Wide-field fundus image from infant ROP screening · acquired on the Natus RetCam Envision · 1440 by 1080 pixels:
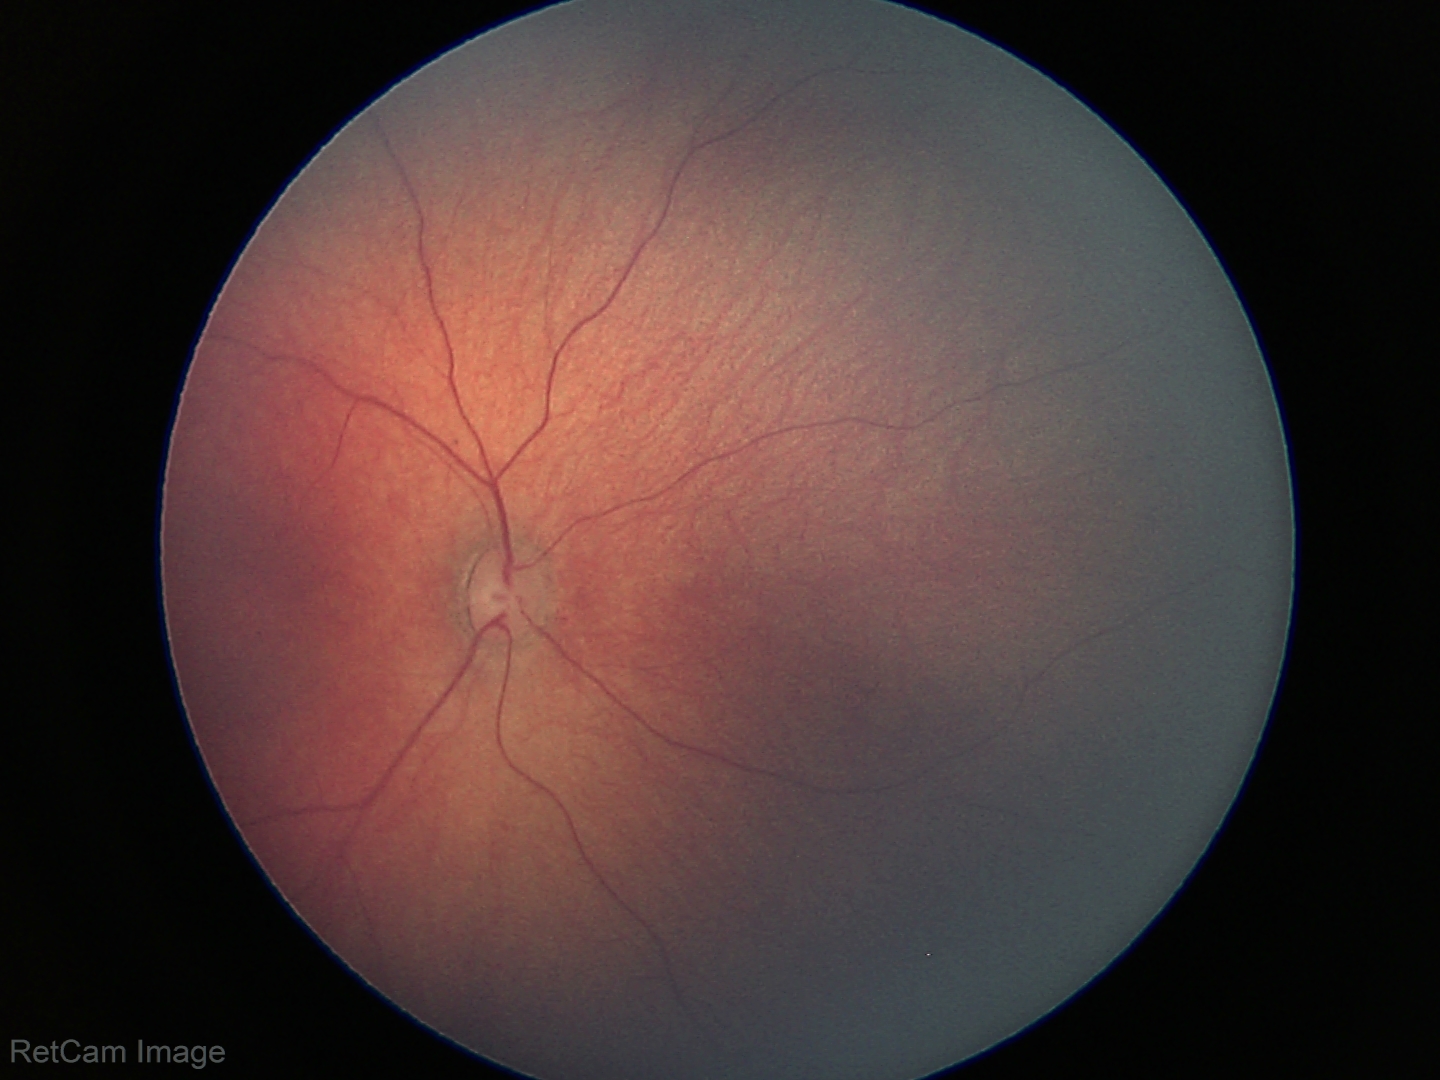

Examination with physiological retinal findings.